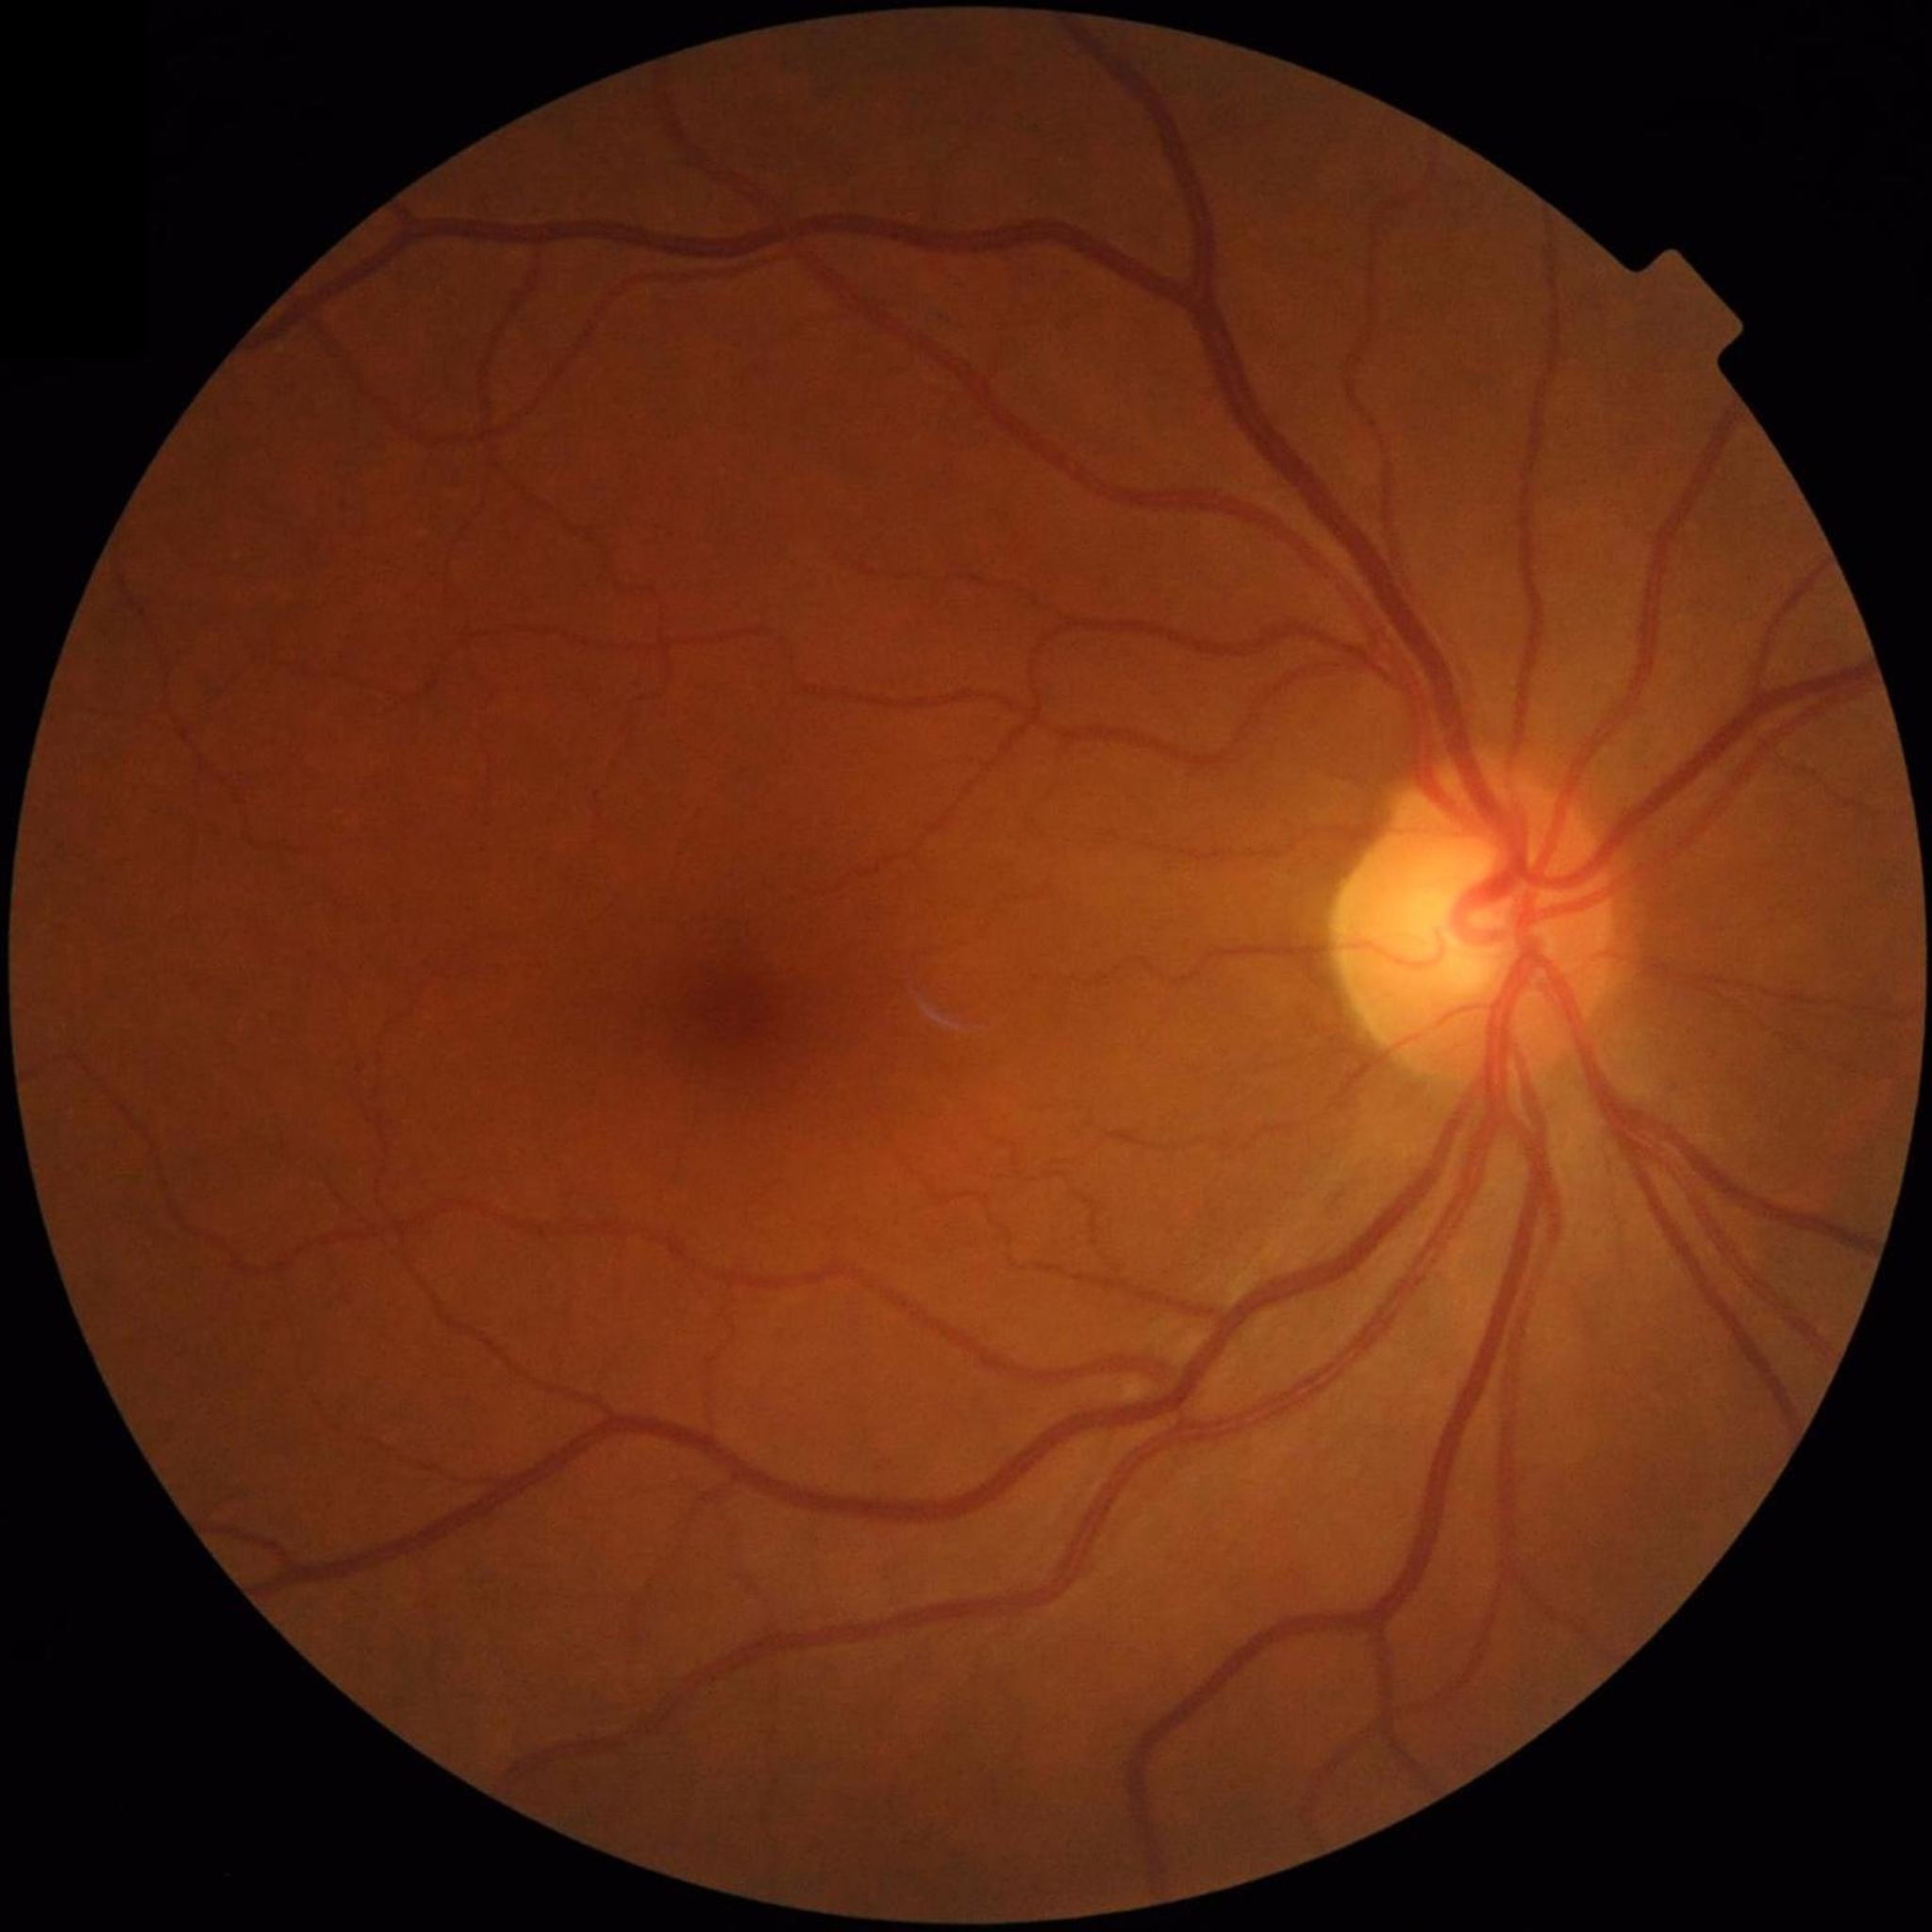

From a control without AMD, diabetic retinopathy, or glaucoma.